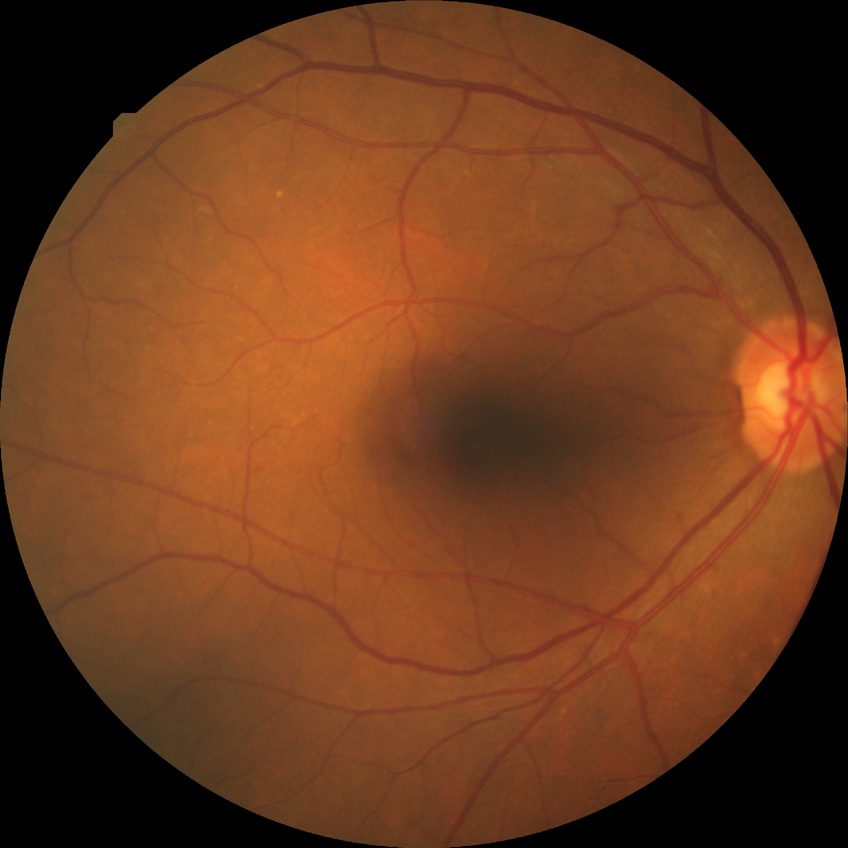 No DR findings. Modified Davis grade is NDR.